Image size 2212x1659 · color fundus image — 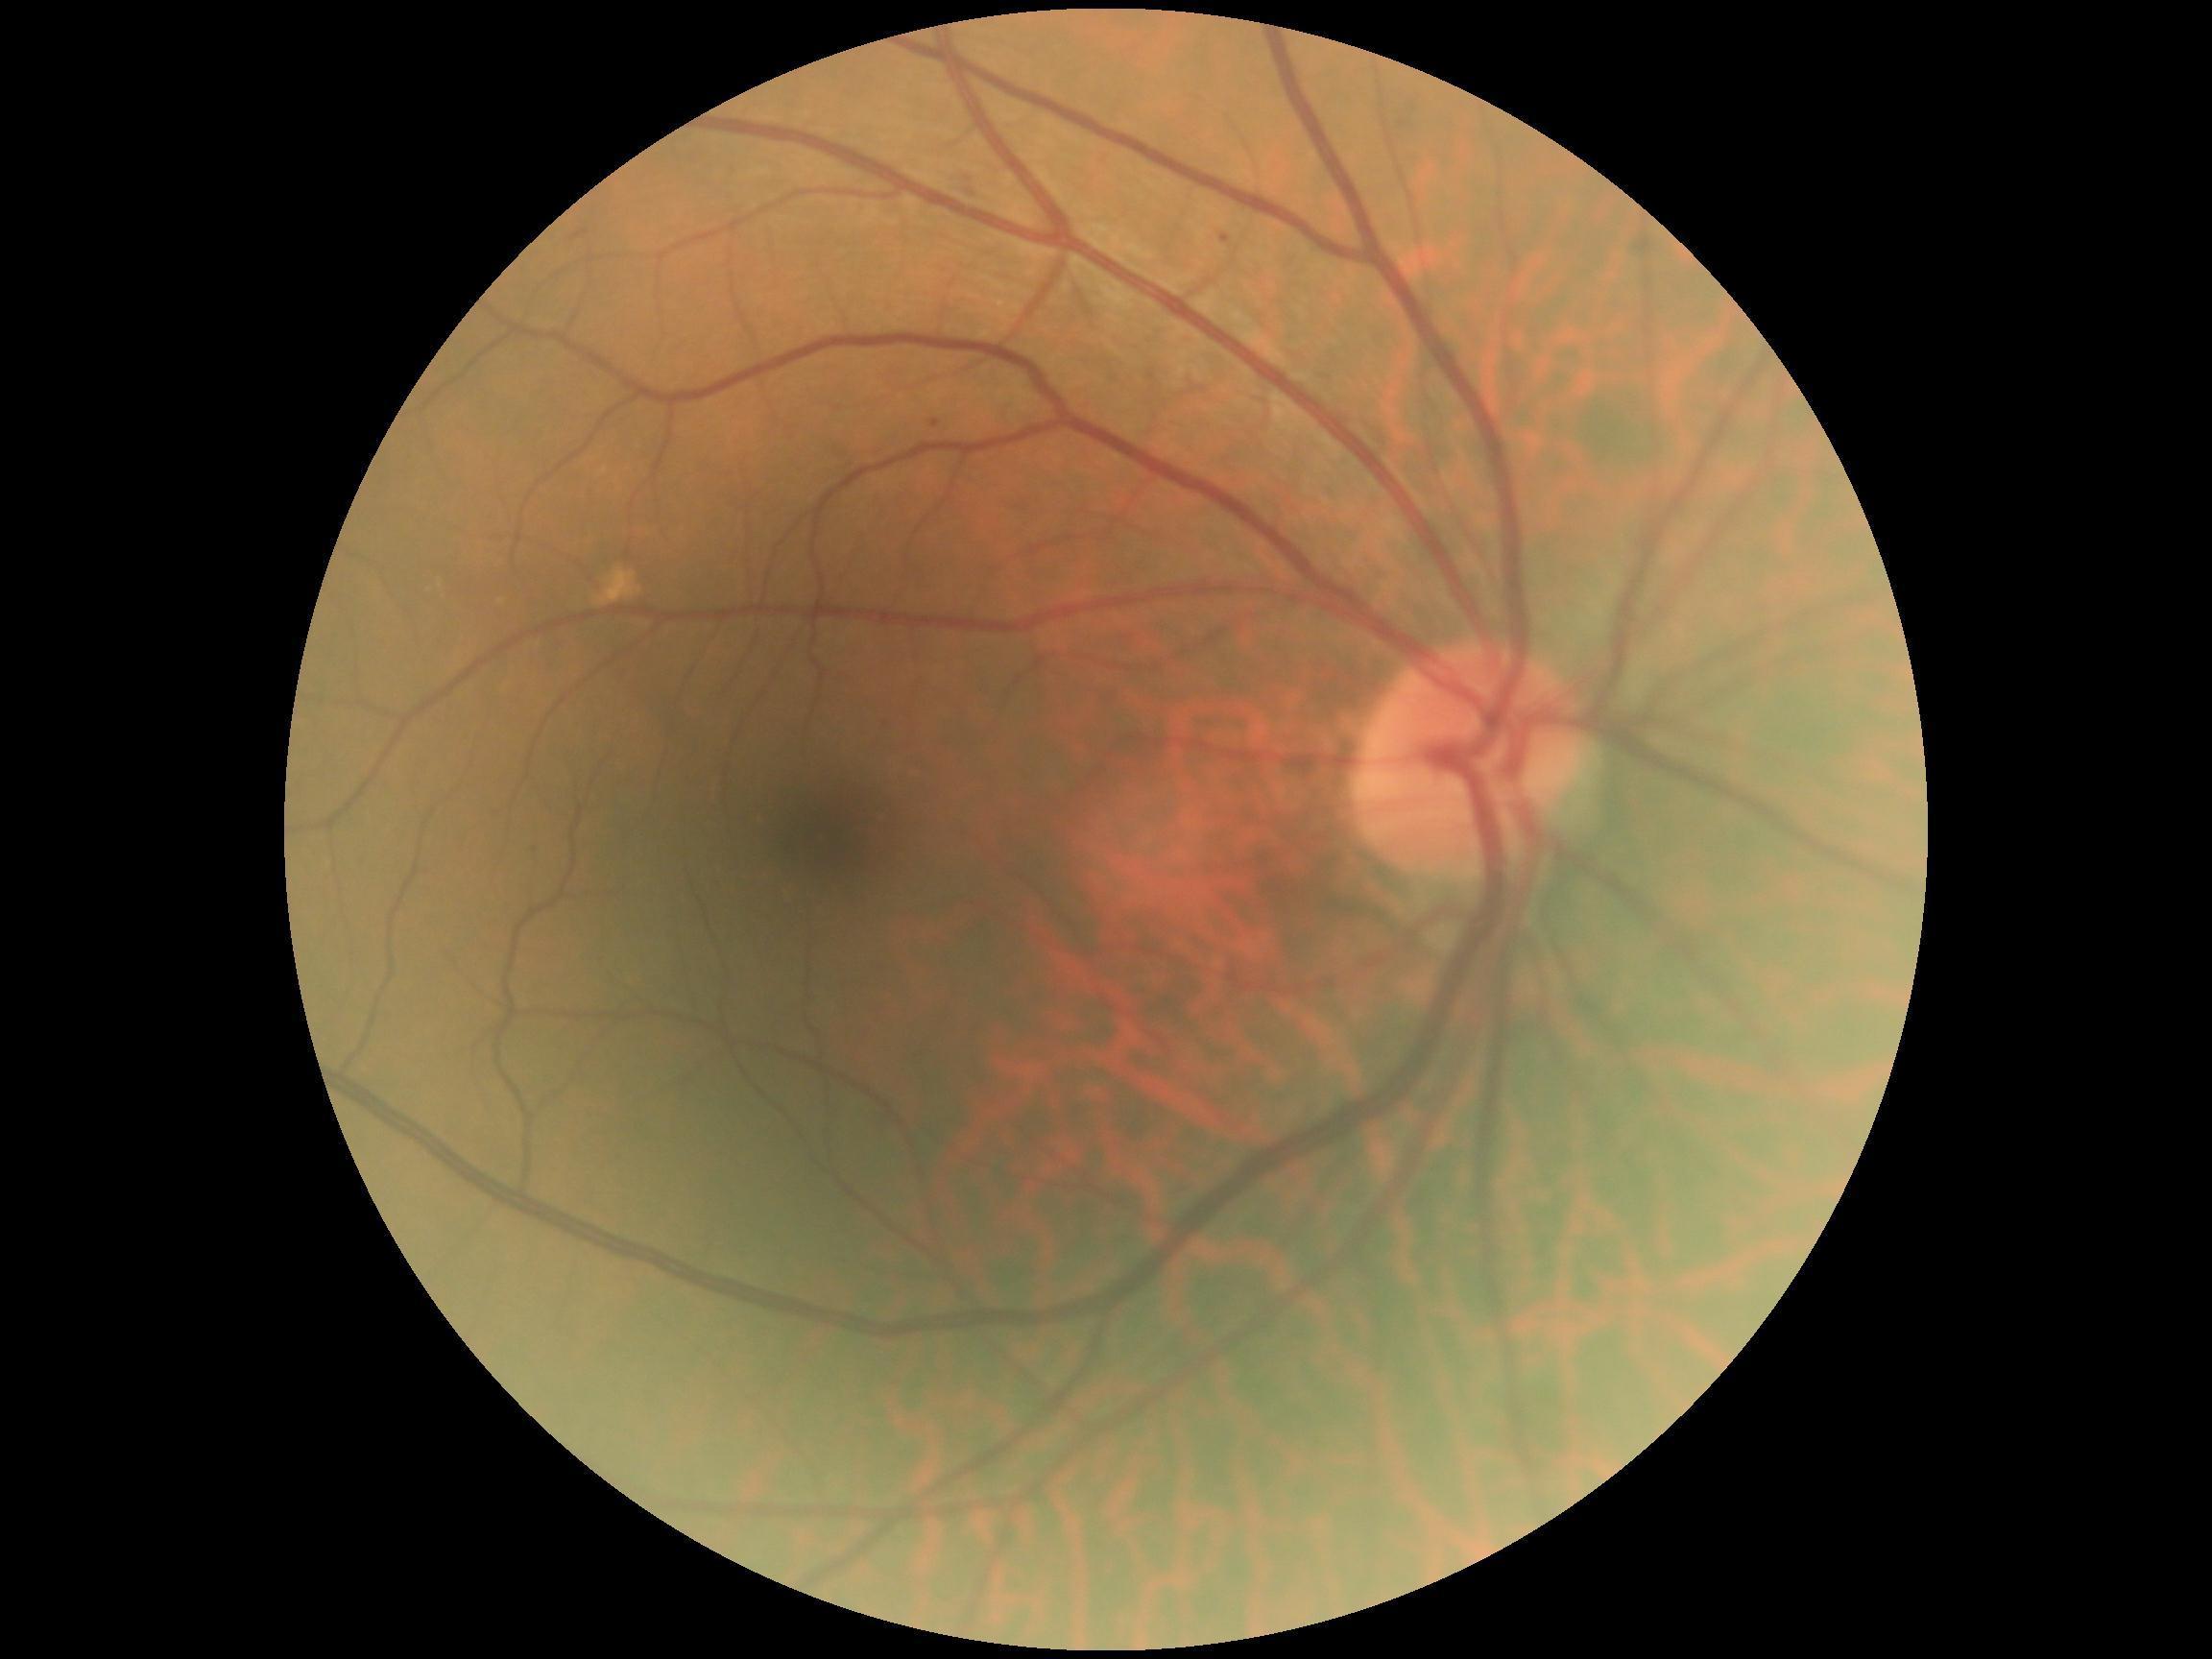
  dr_grade: mild NPDR (grade 1) — presence of microaneurysms only